2212 x 1659 pixels; 45° field of view.
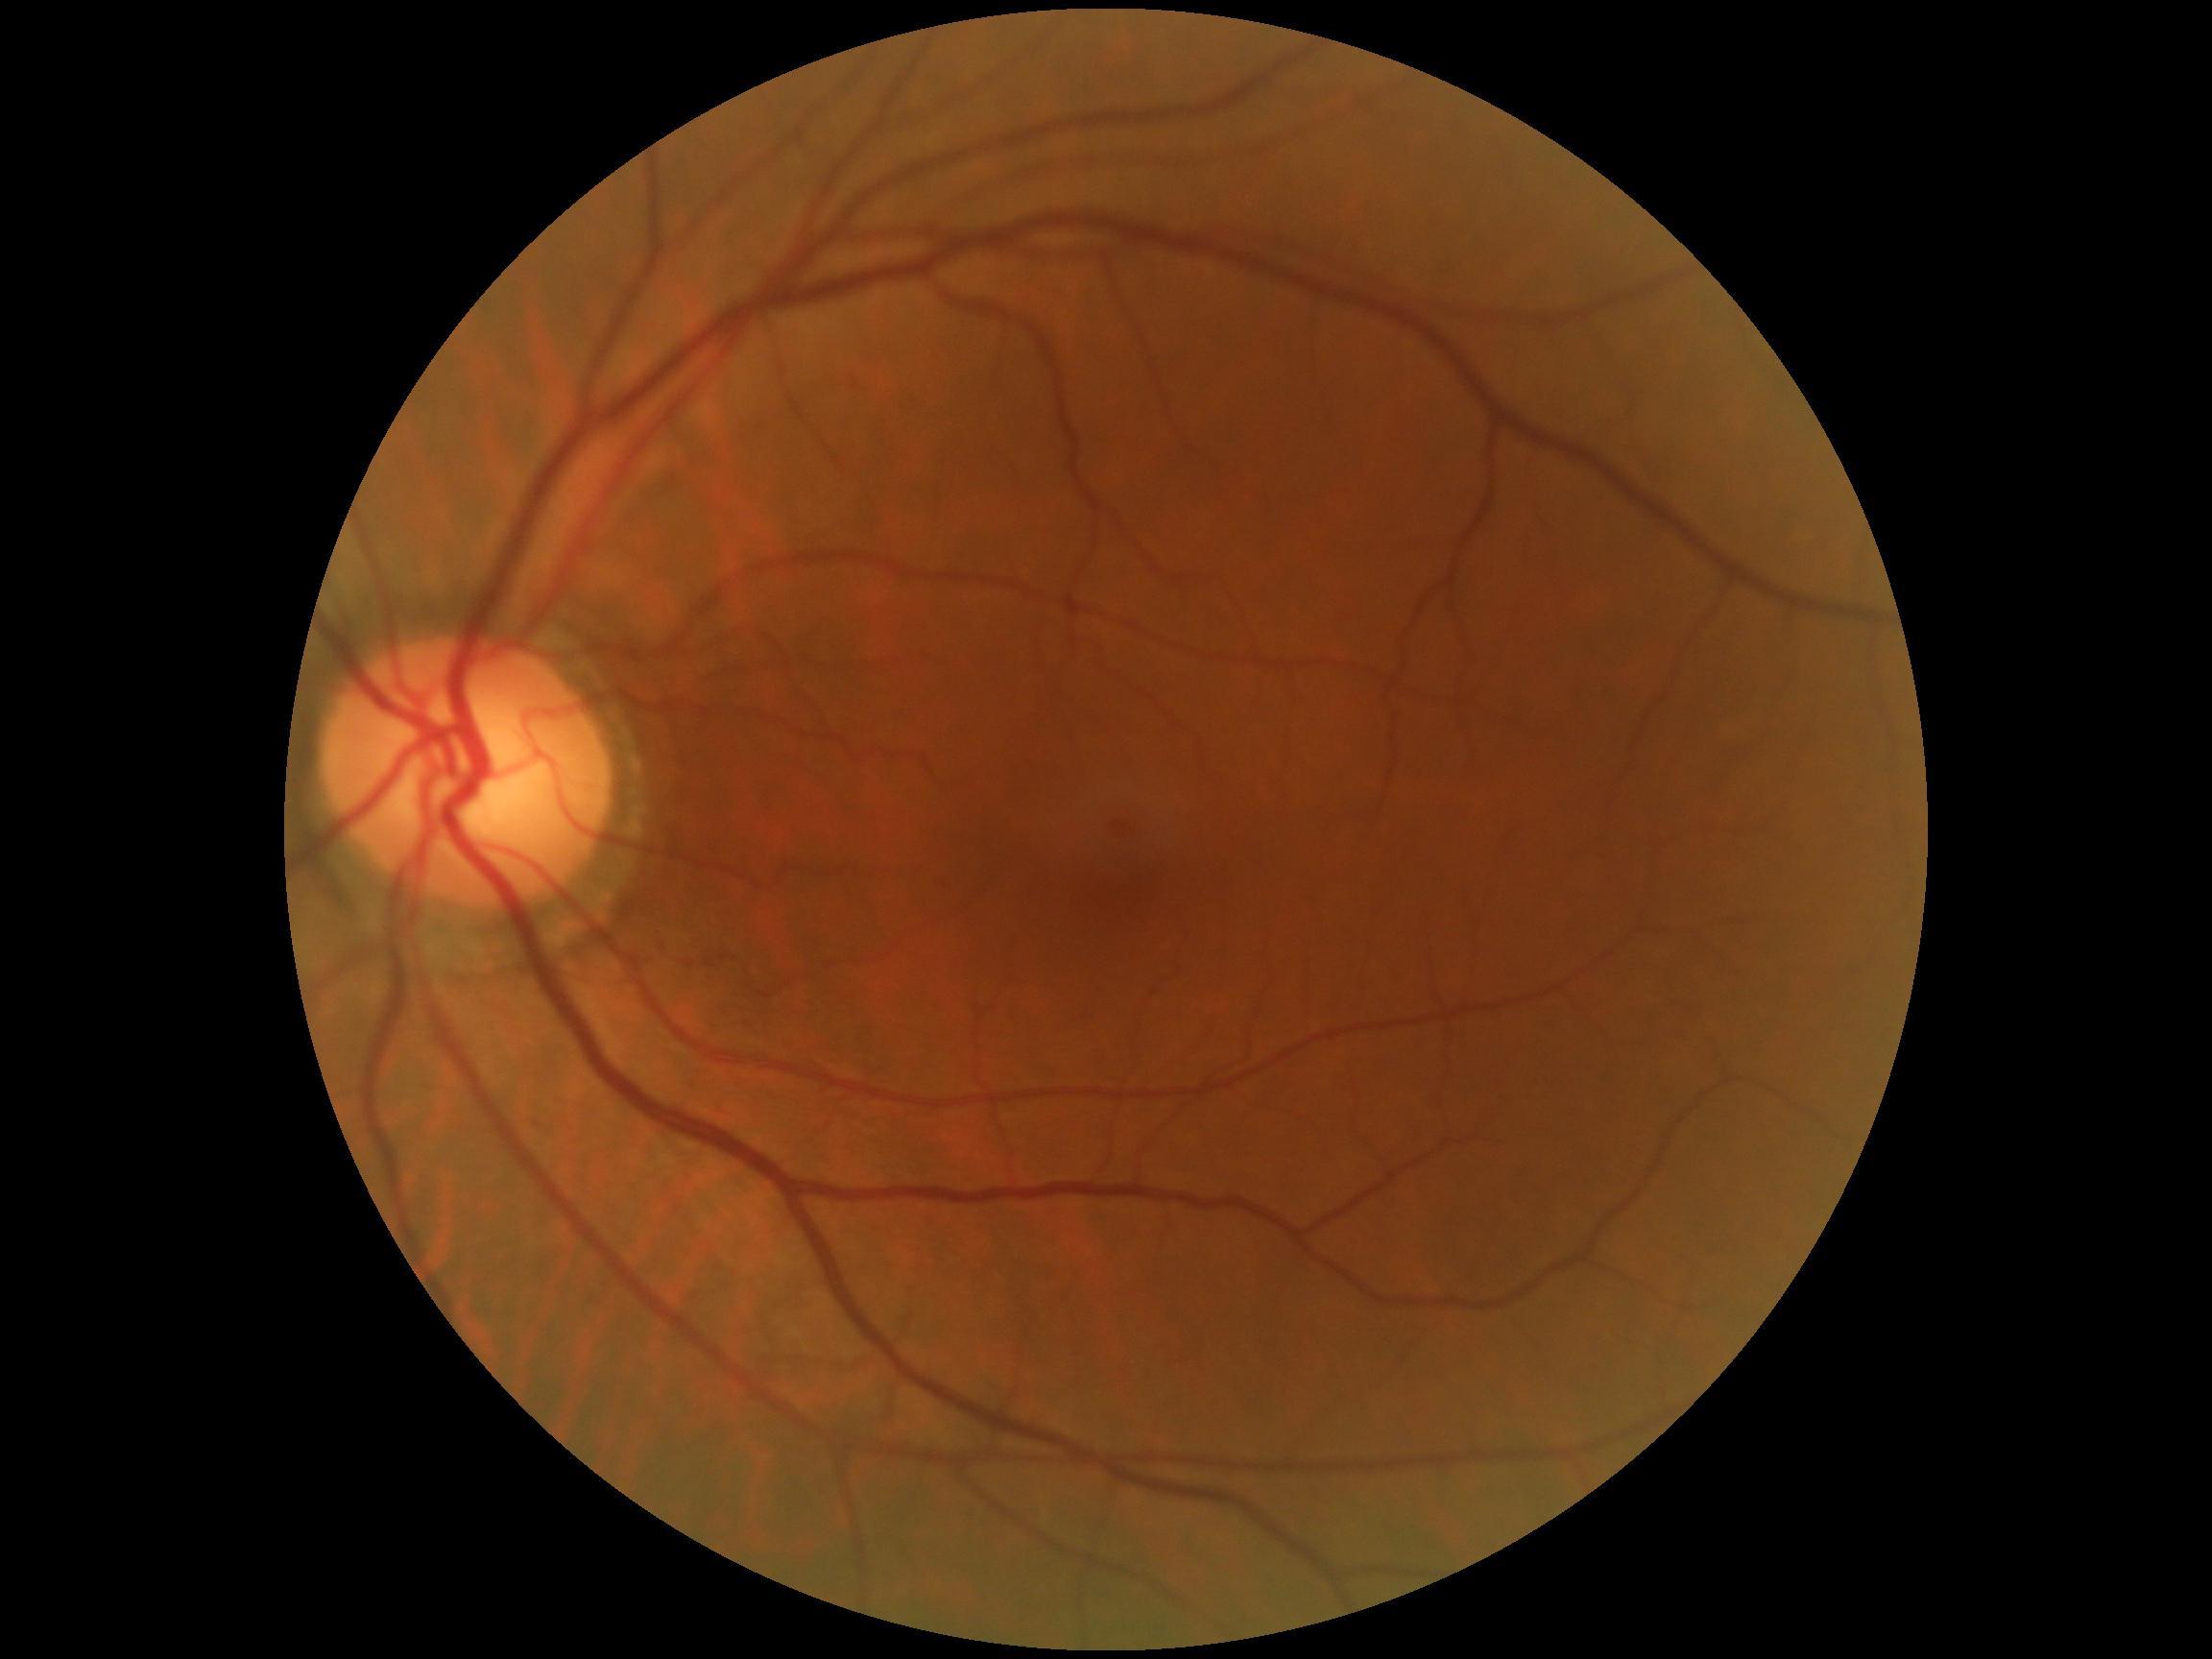

Diabetic retinopathy is 0.